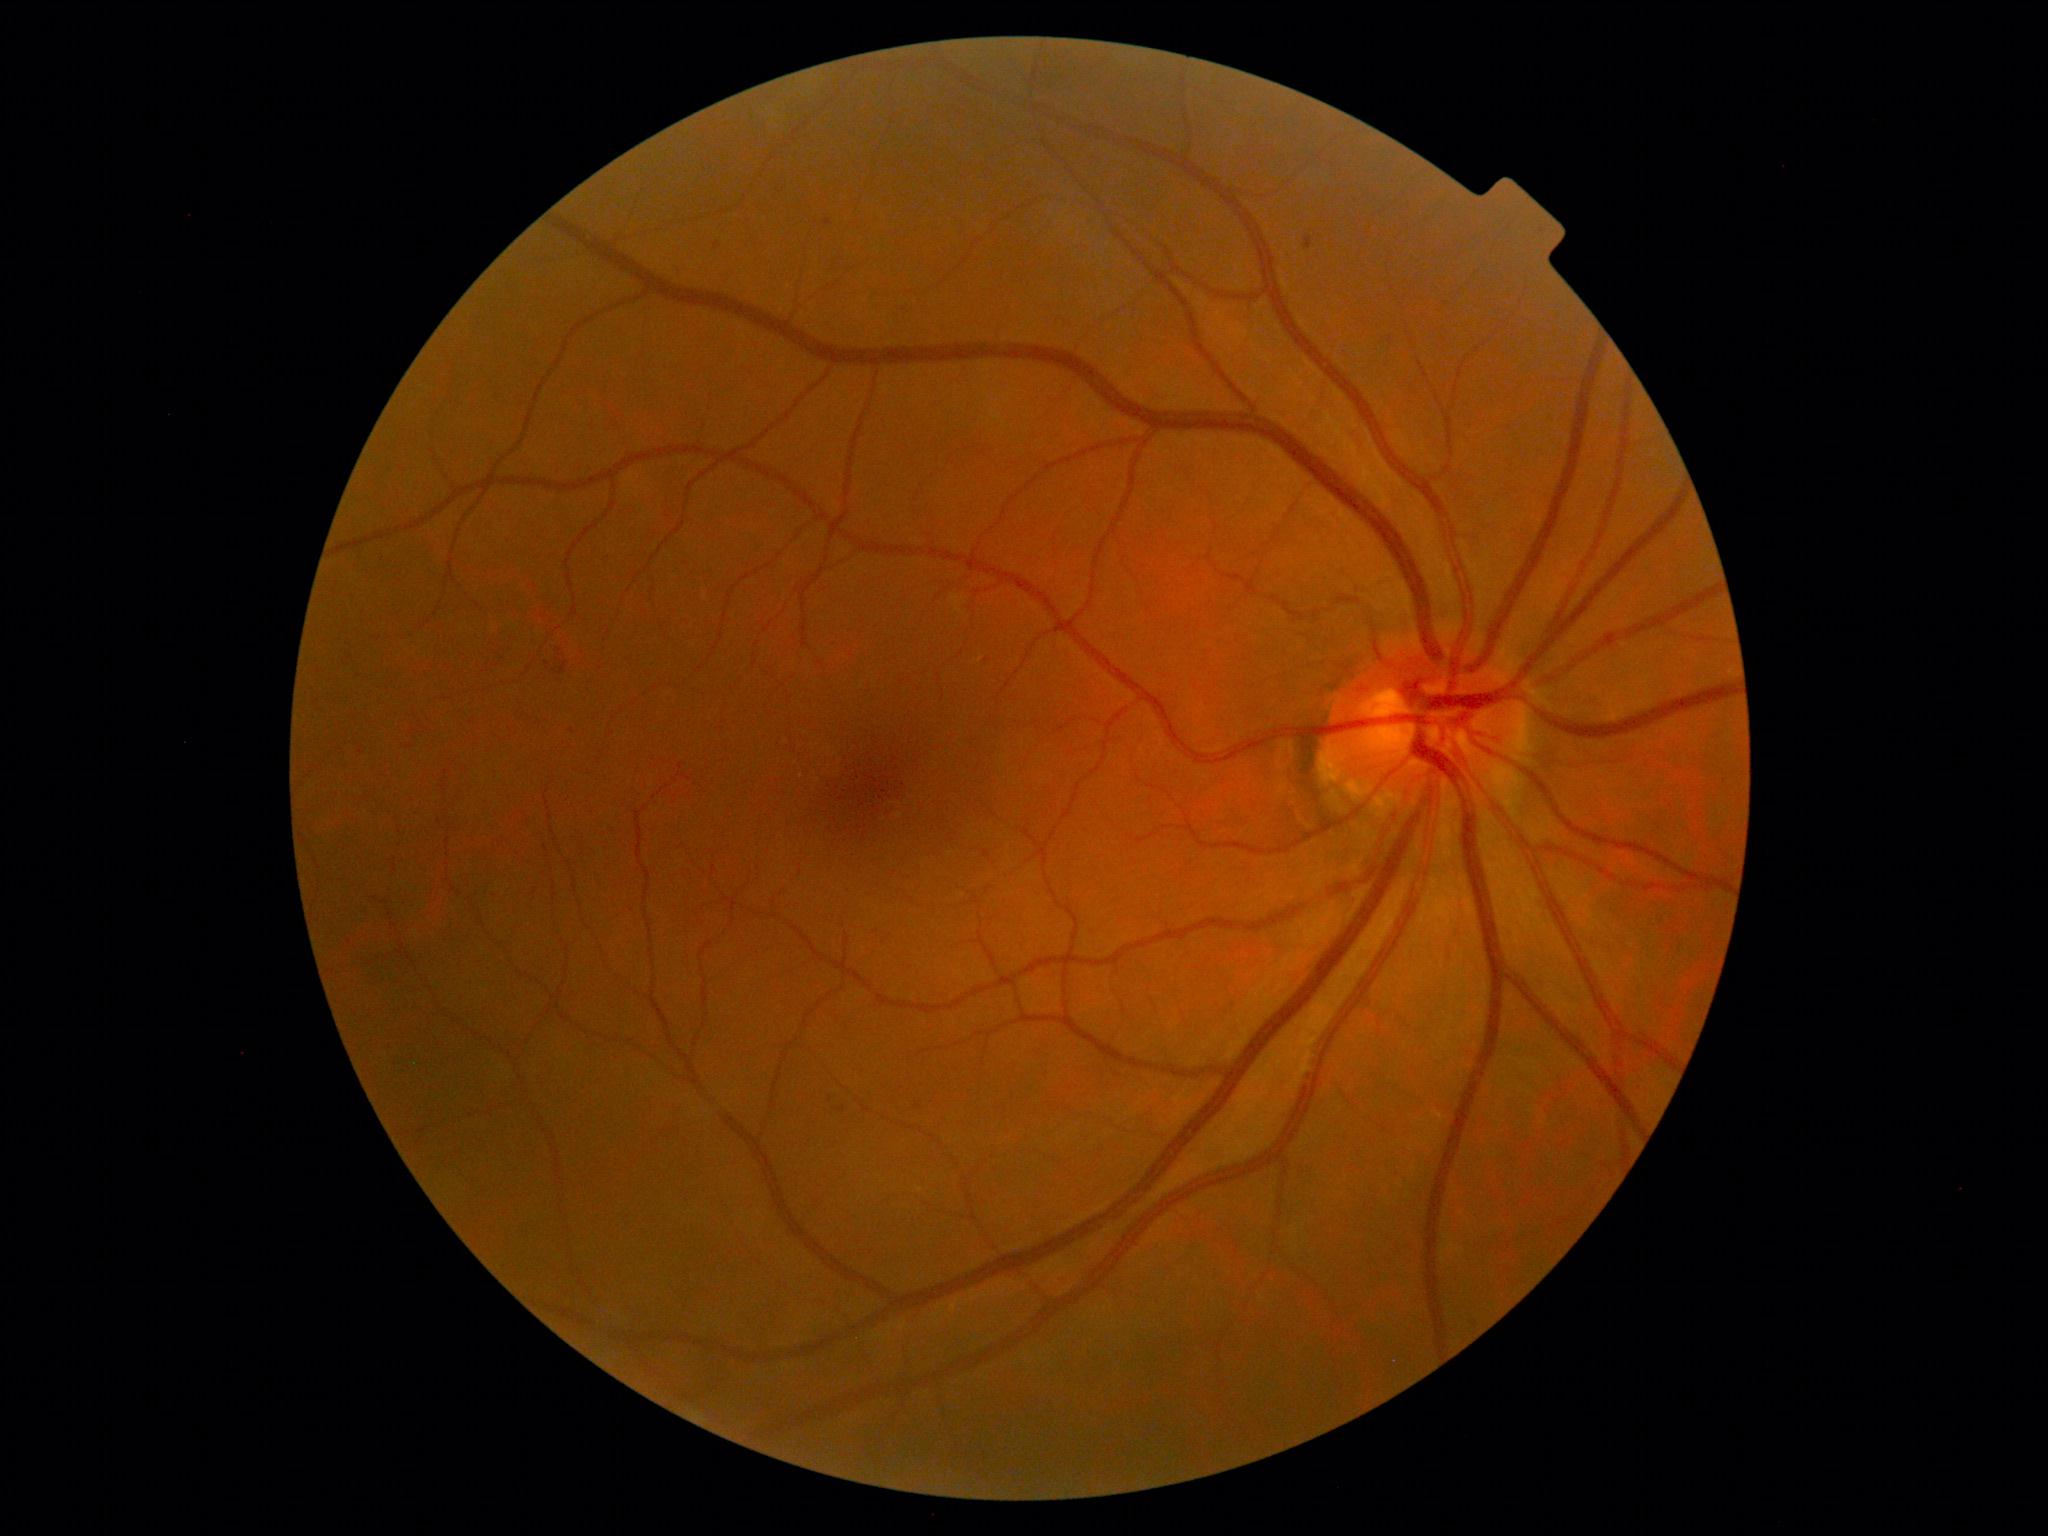 DR stage = 2/4